Color fundus image:
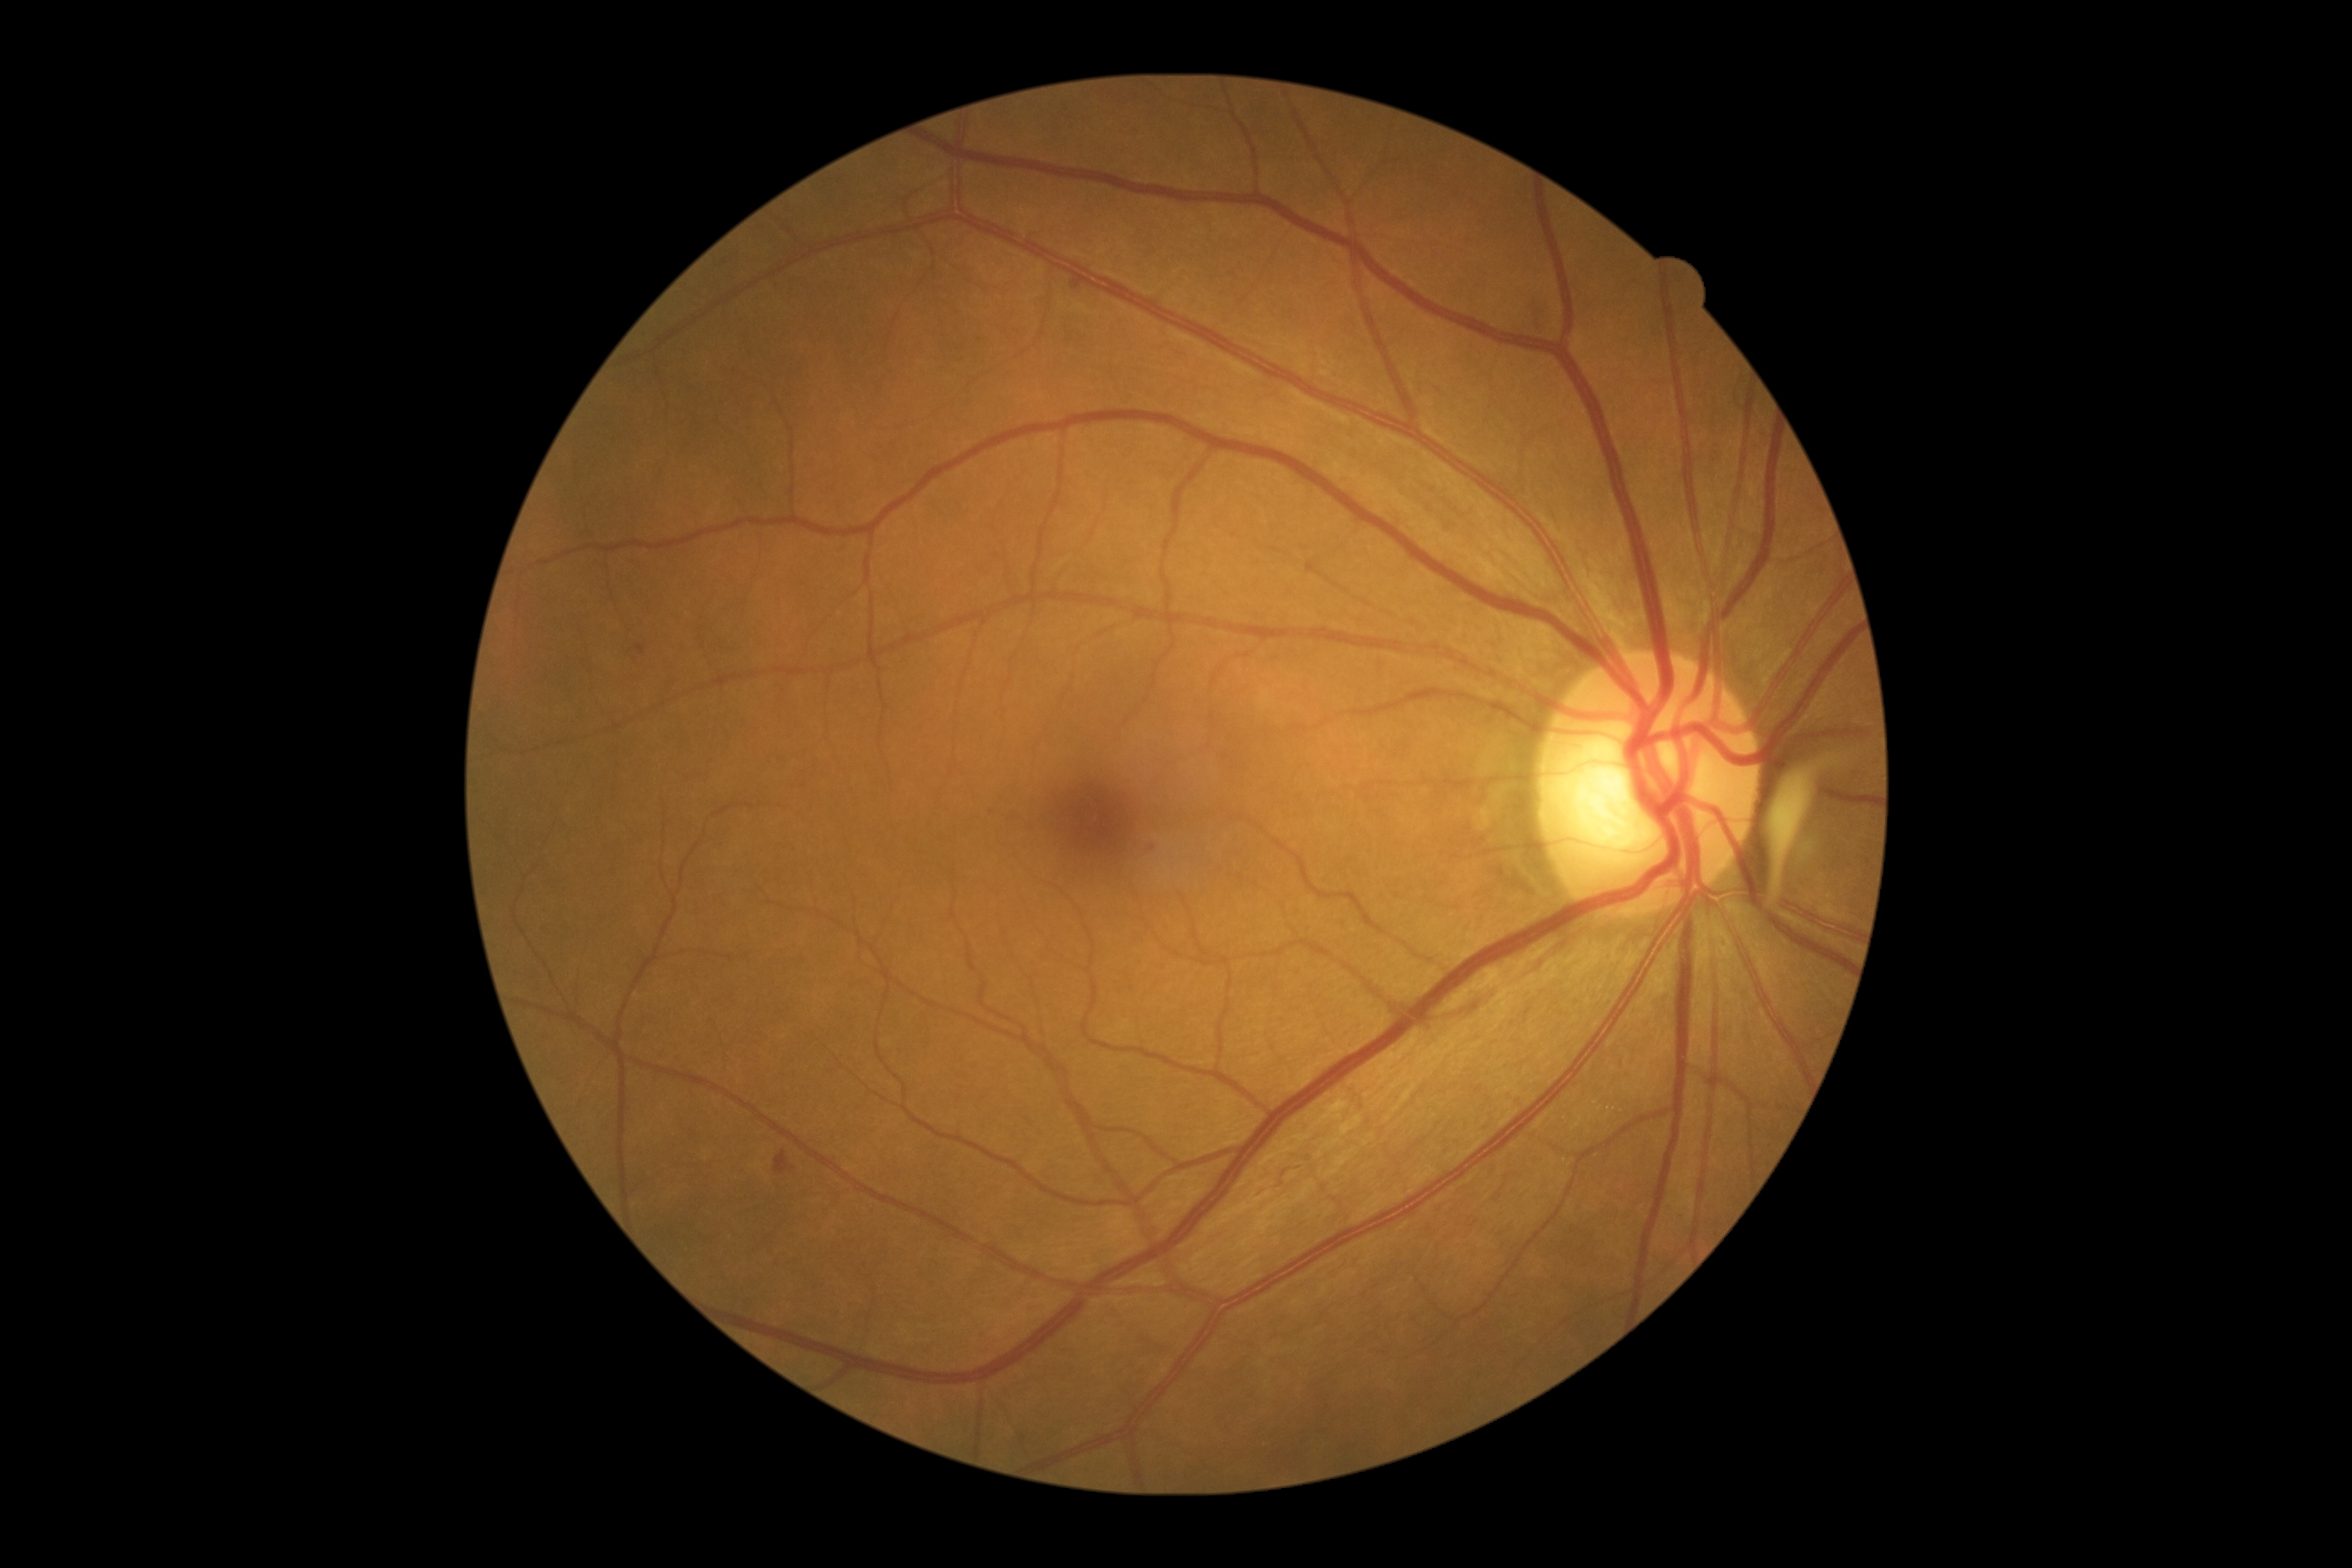 partial: true
dr_grade: 2
dr_grade_name: moderate NPDR
lesions:
  ma:
    - bbox=(1144, 843, 1153, 850)
  ma_small:
    - (x=991, y=809)
    - (x=641, y=649)
    - (x=1071, y=280)
  se: []
  ex: []
  he:
    - bbox=(774, 1150, 789, 1173)